FOV: 45 degrees. Color fundus photograph
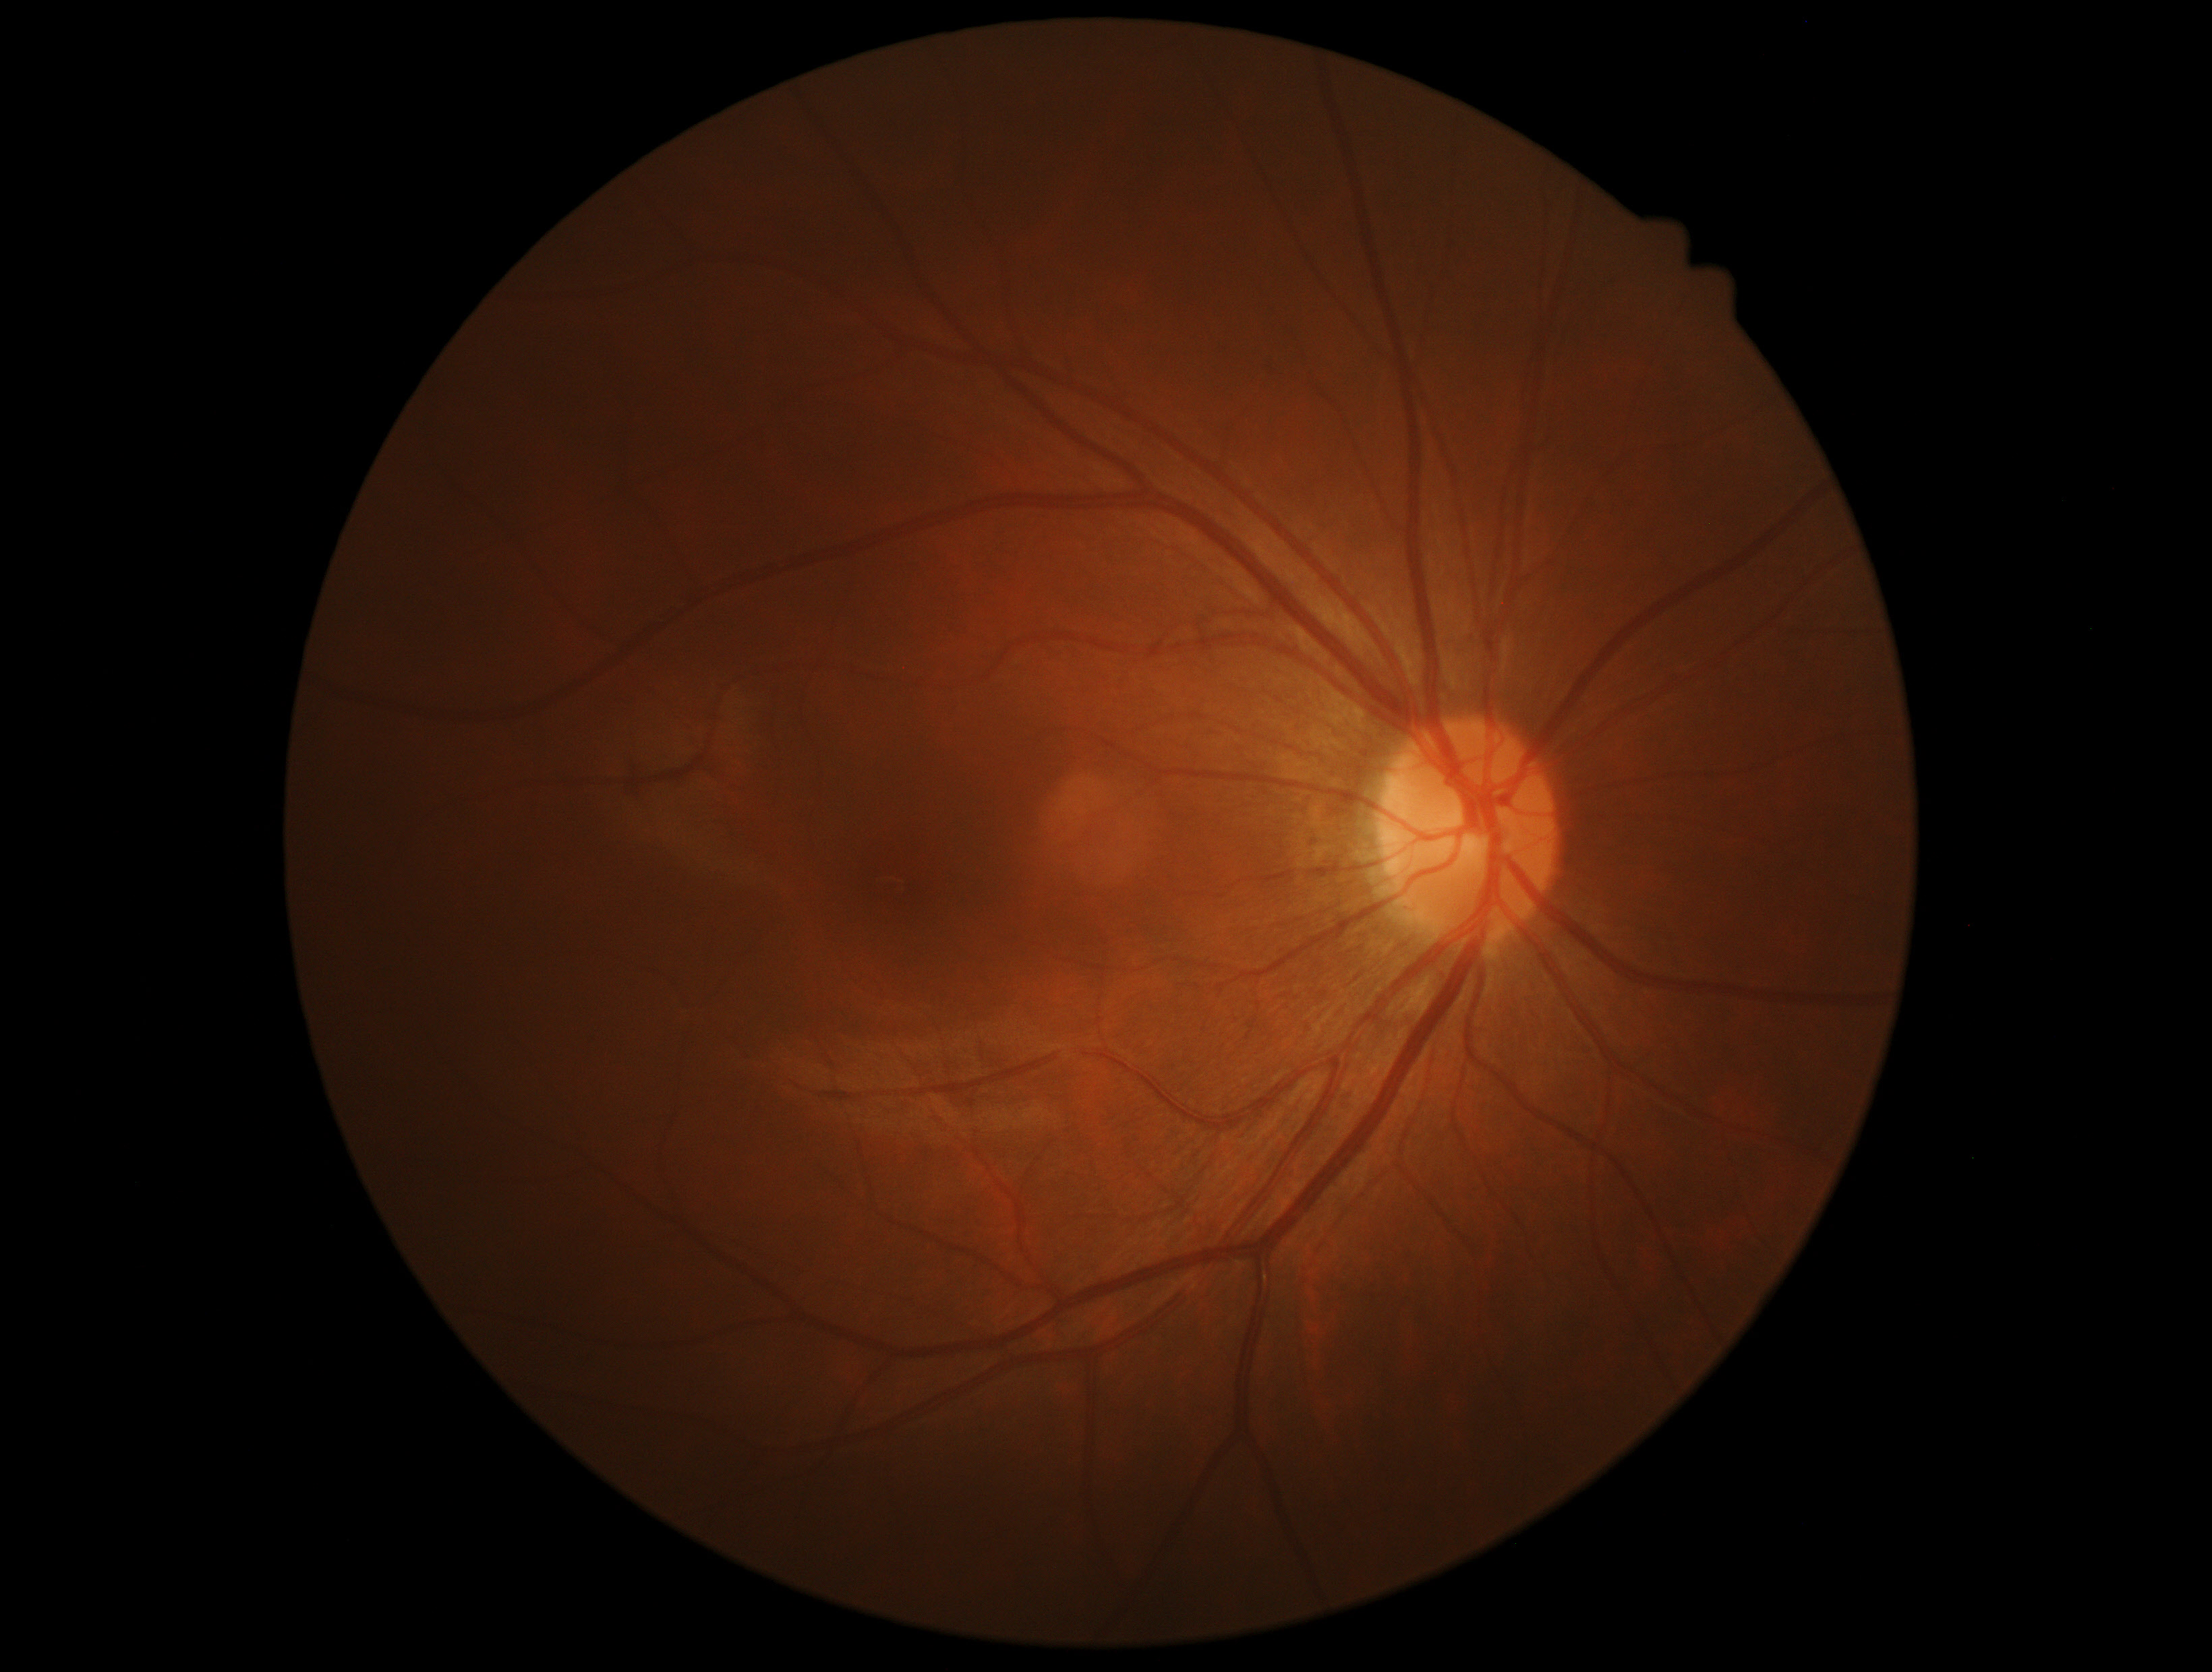 DR impression: no signs of DR; DR severity: no apparent diabetic retinopathy (grade 0).